No pharmacologic dilation, FOV: 45 degrees.
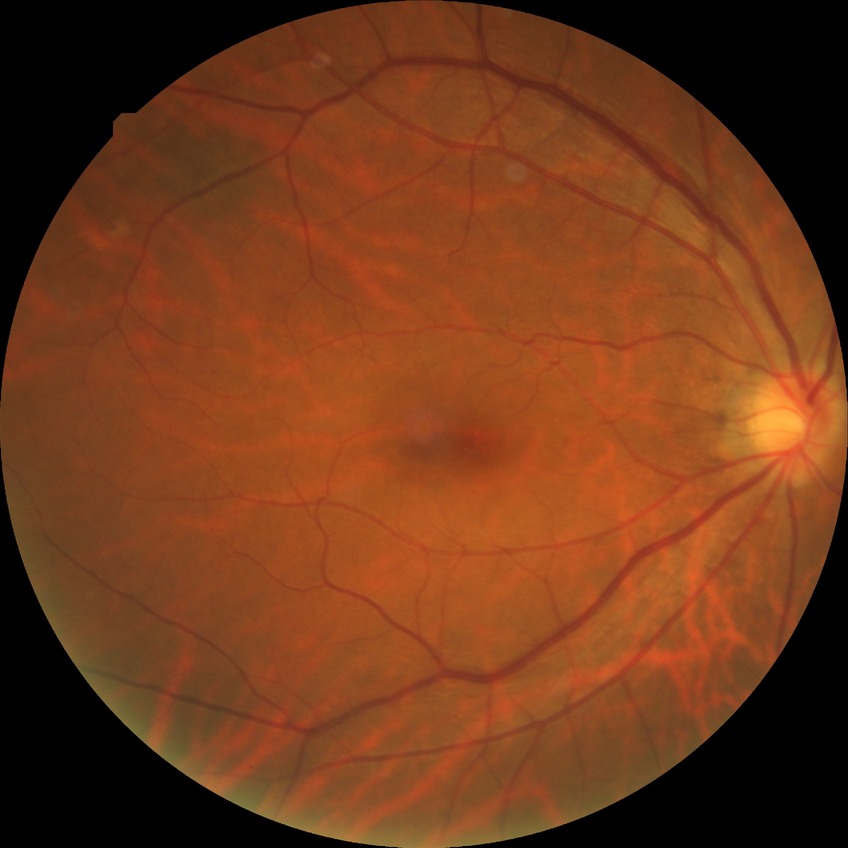
Annotations:
* diabetic retinopathy (DR) — simple diabetic retinopathy (SDR)